1920 by 1440 pixels:
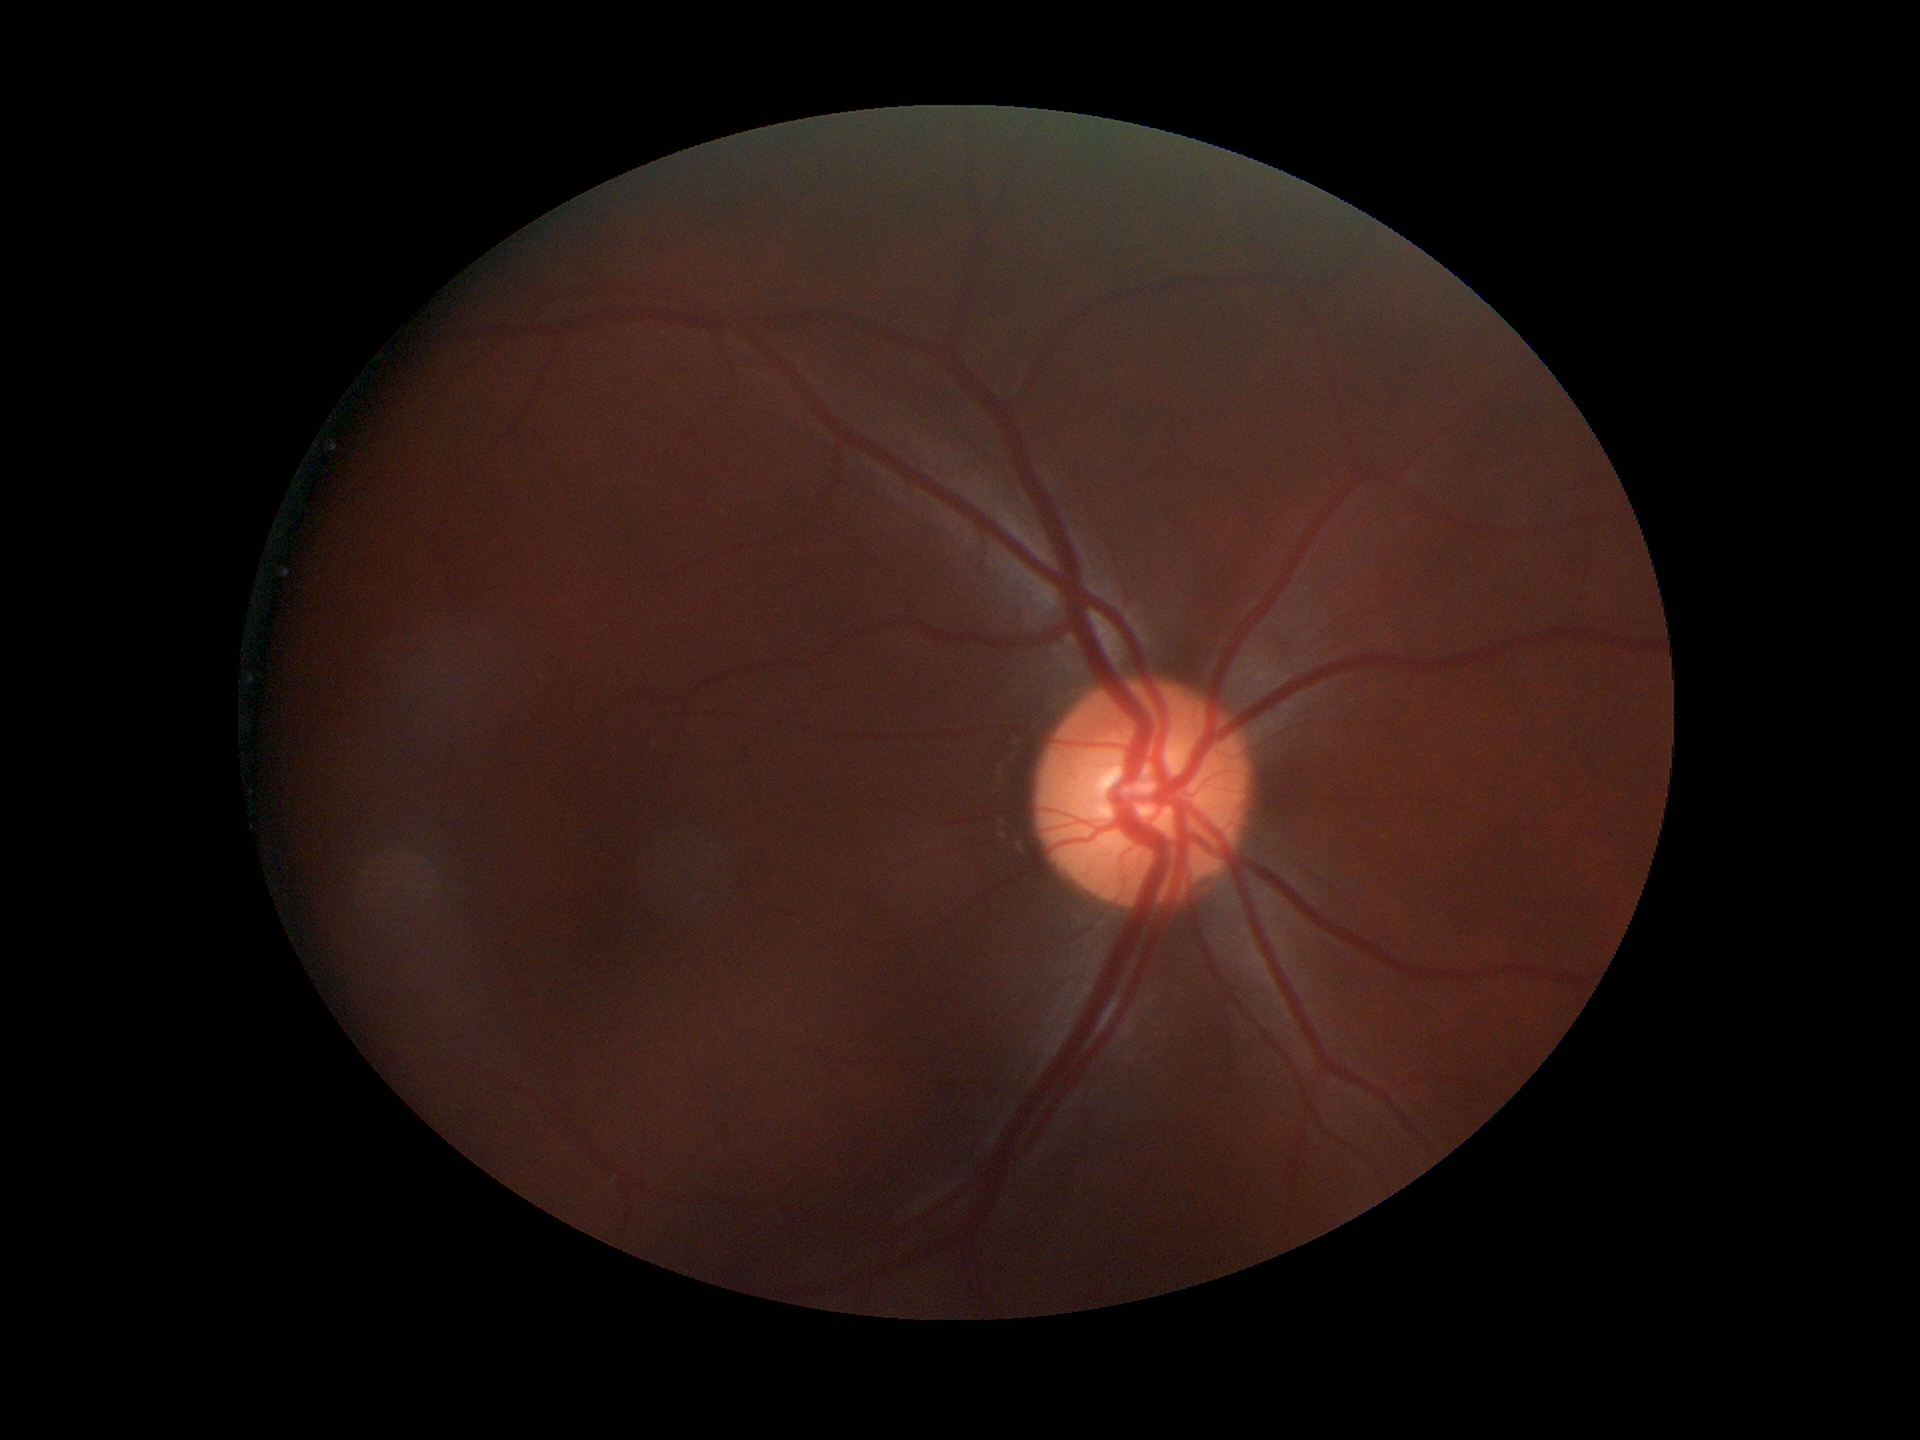

ACDR: 0.24.
VCDR of 0.51.
No evidence of glaucoma (5/5 ophthalmologists in agreement).